Without pupil dilation; color fundus photograph; 45-degree field of view; NIDEK AFC-230.
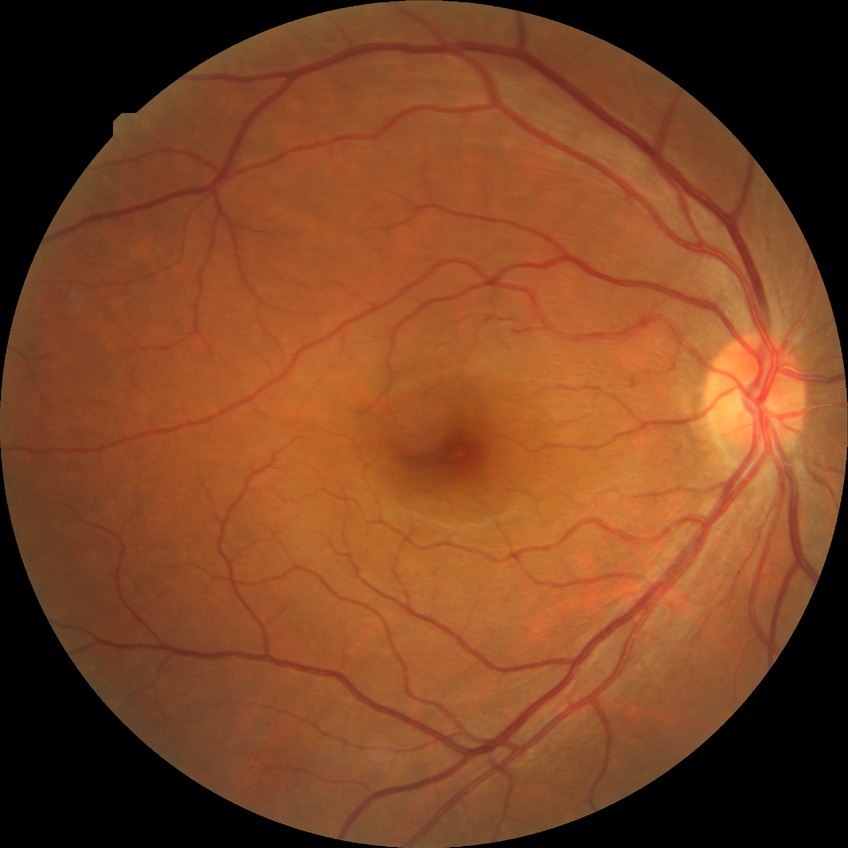 Retinopathy stage: no diabetic retinopathy.